Dilated-pupil acquisition · 2361x1568: 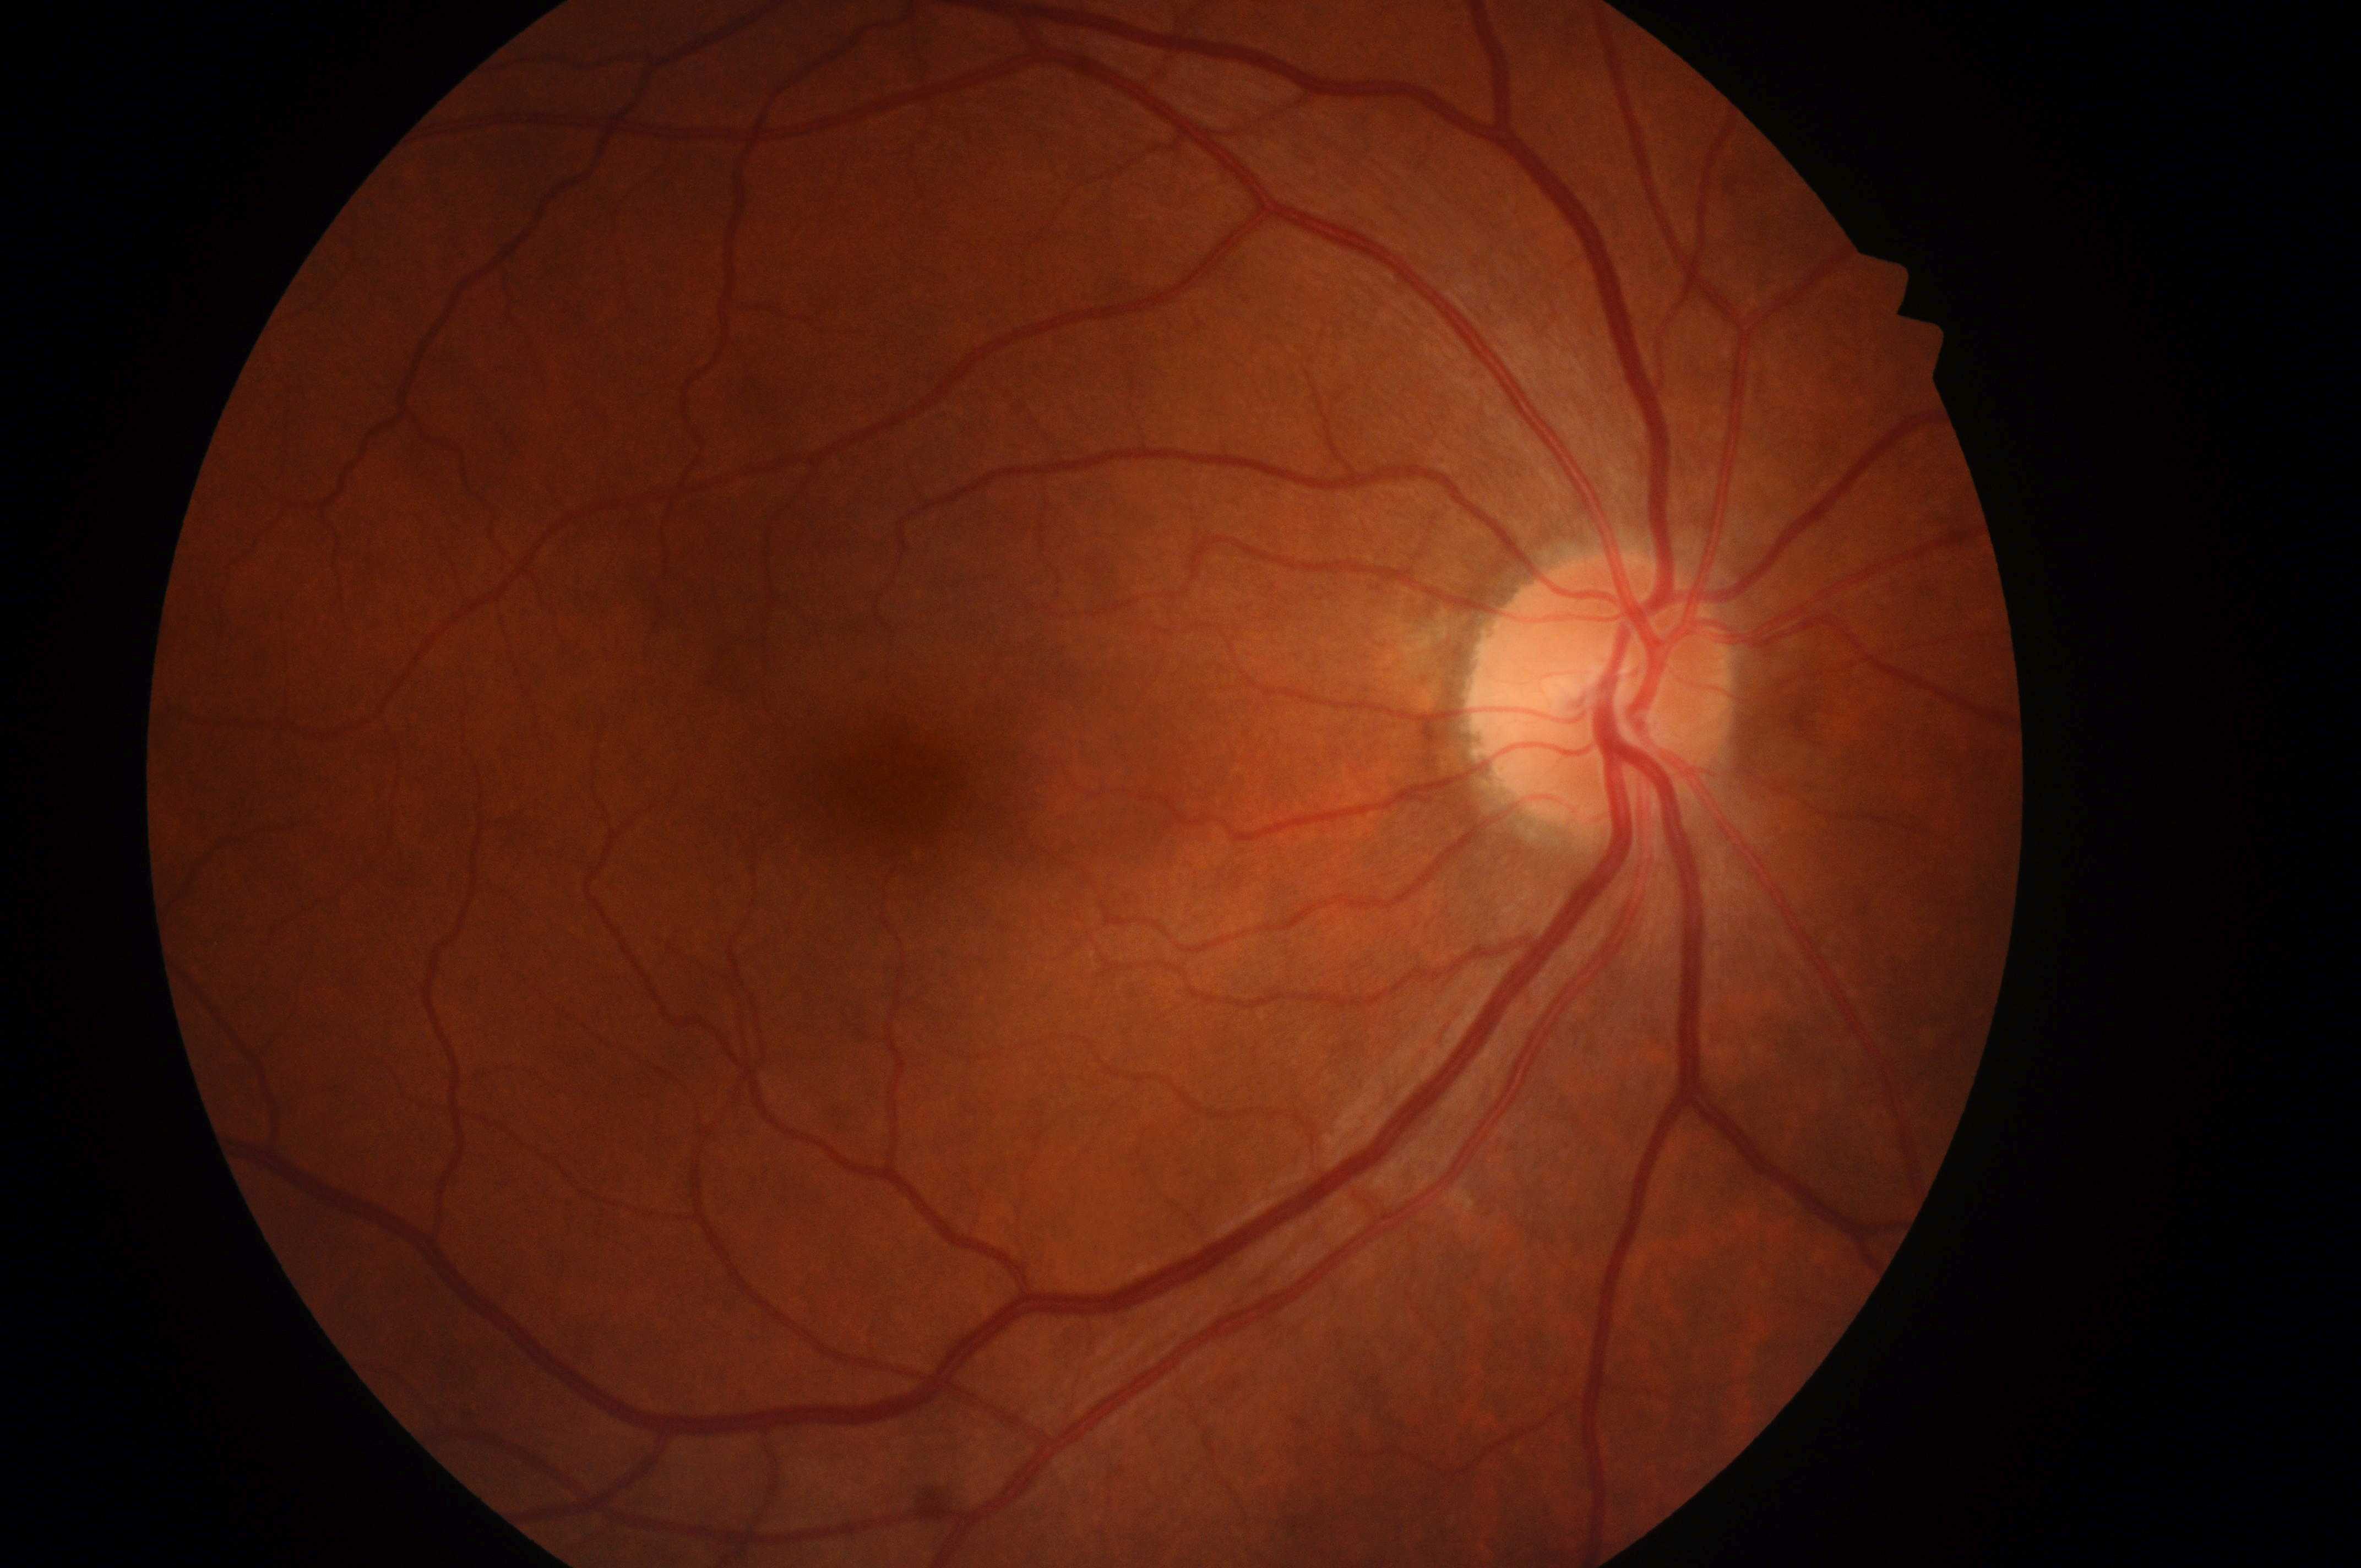

Q: Macular edema risk?
A: no risk (grade 0)
Q: What is the laterality?
A: the right eye
Q: Locate the optic disc.
A: x=1601, y=701
Q: Where is the fovea?
A: x=895, y=802
Q: Is there DR or DME?
A: No signs of diabetic retinopathy or diabetic macular edema
Q: DR stage?
A: no apparent diabetic retinopathy (grade 0)